2361 by 1568 pixels.
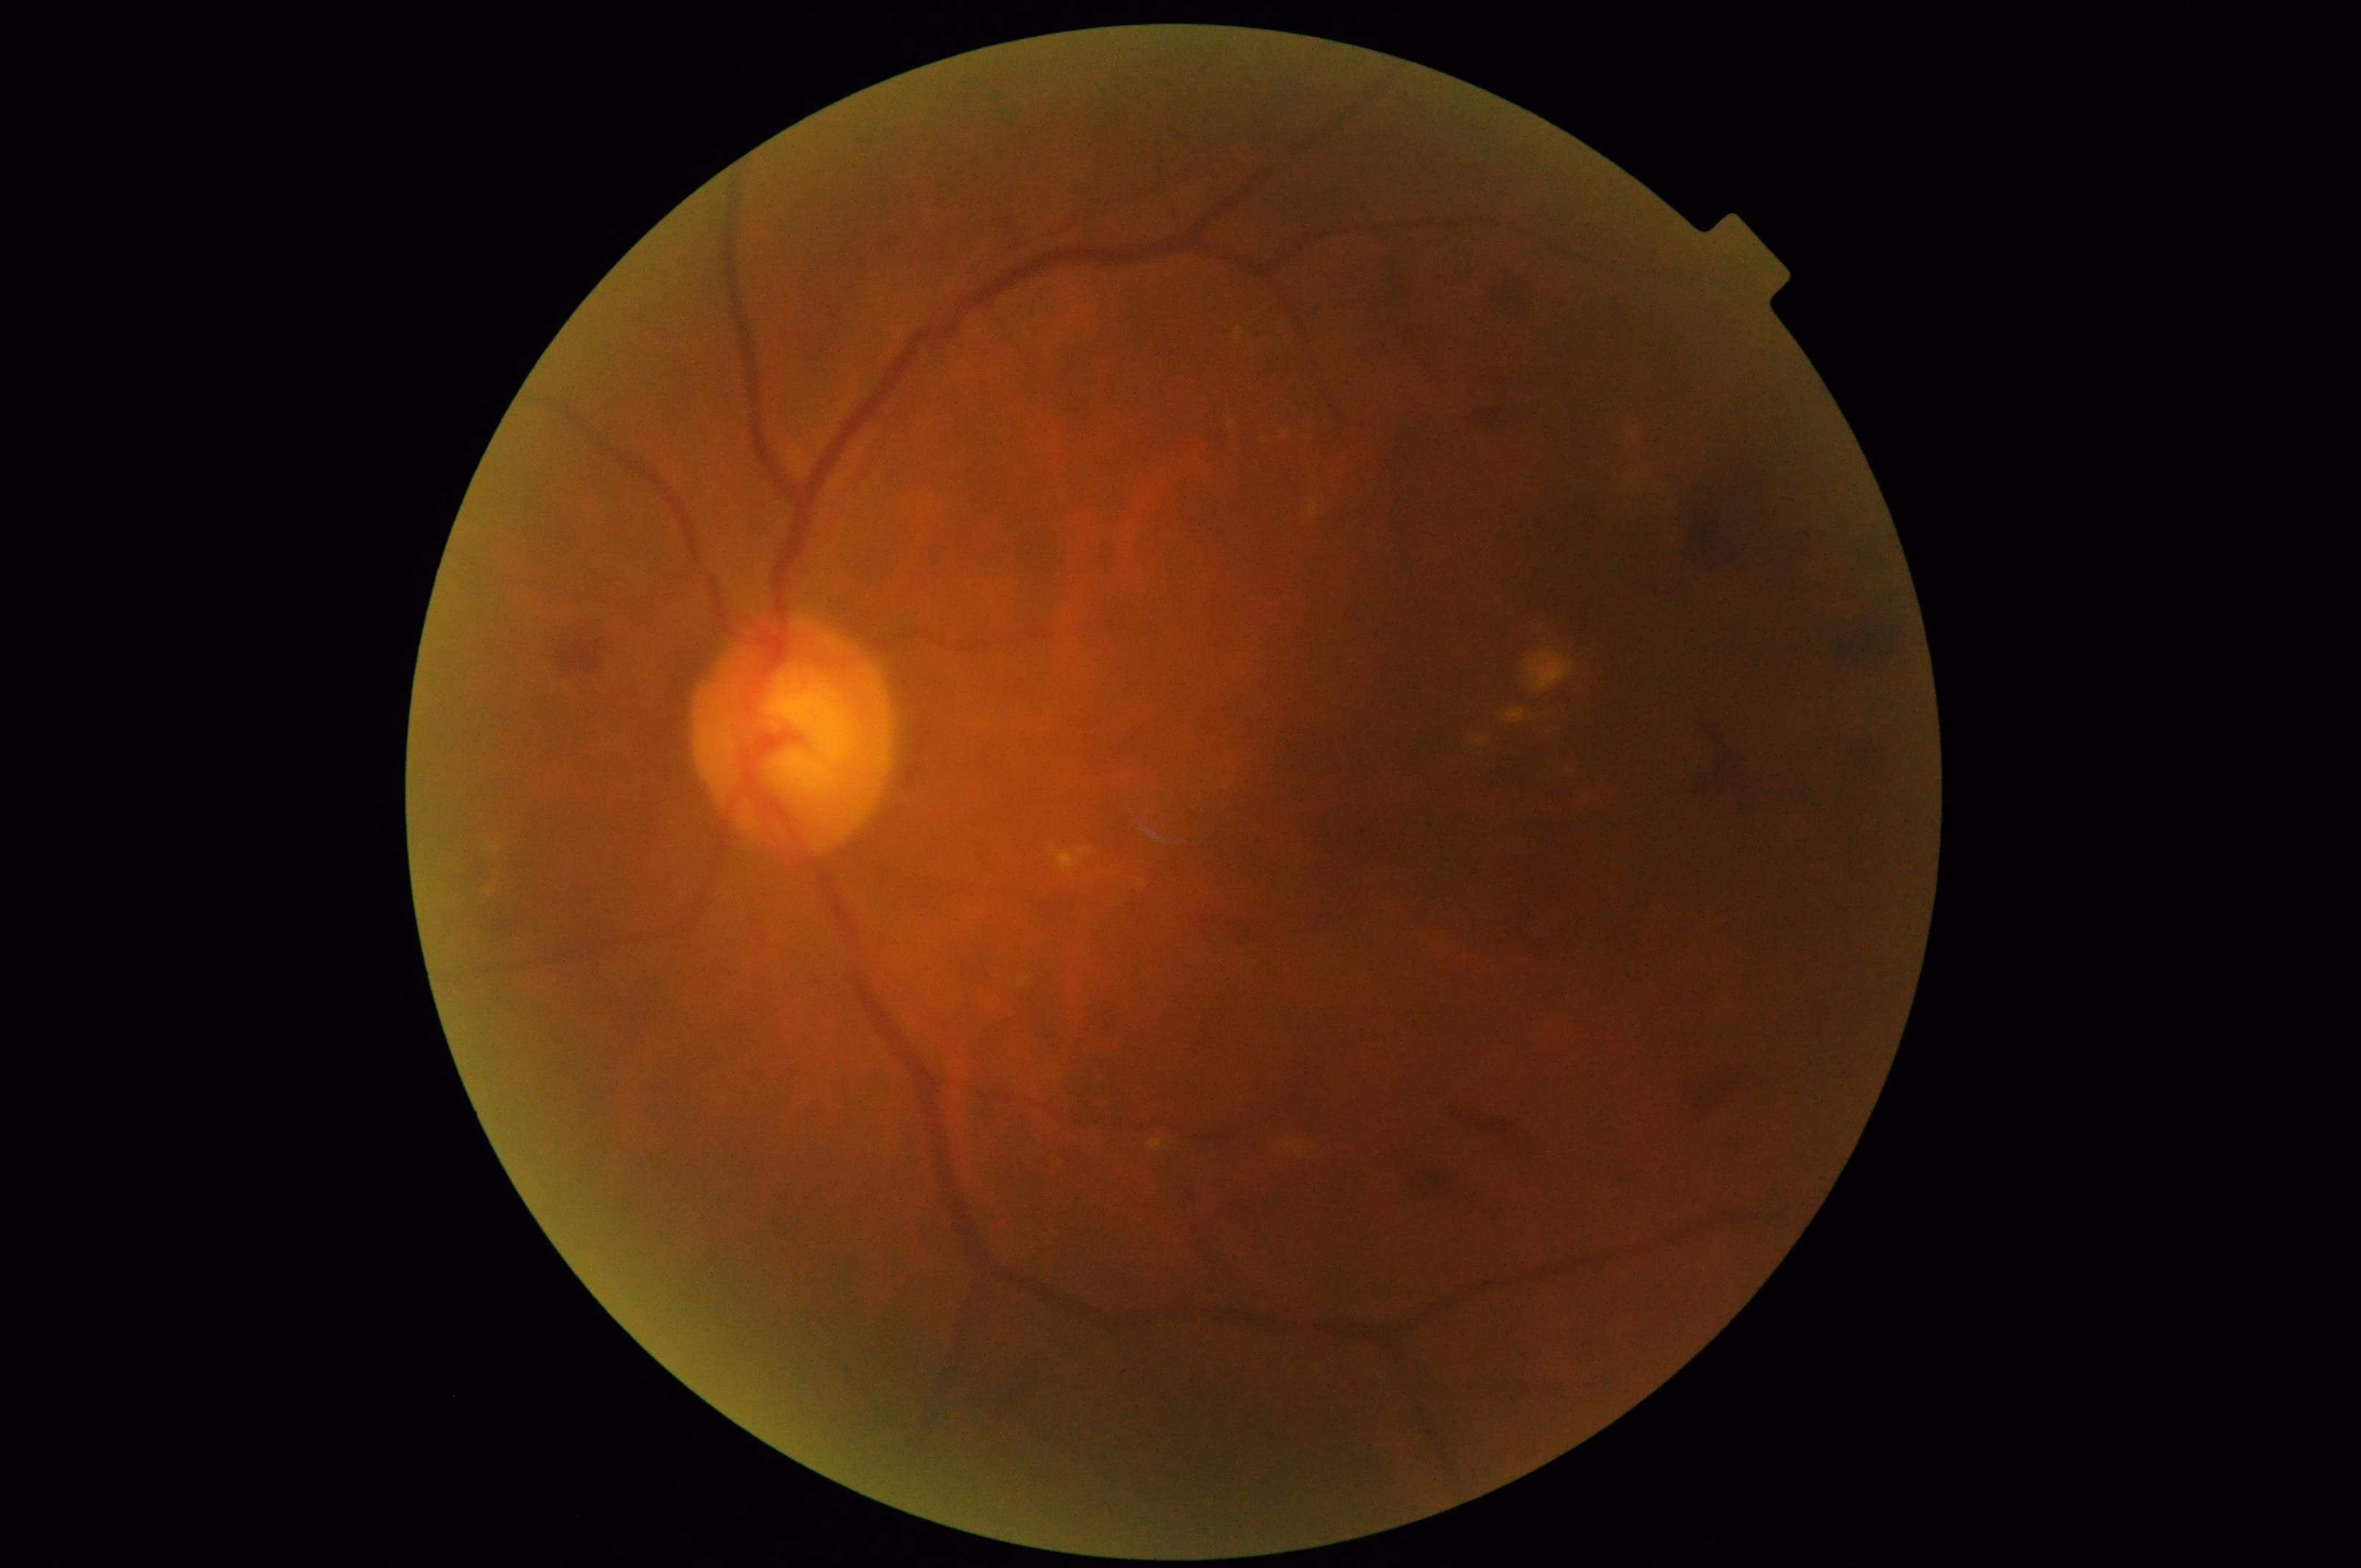

There is over- or under-exposure or a color cast. Good dynamic range.